1536 x 1152 pixels: 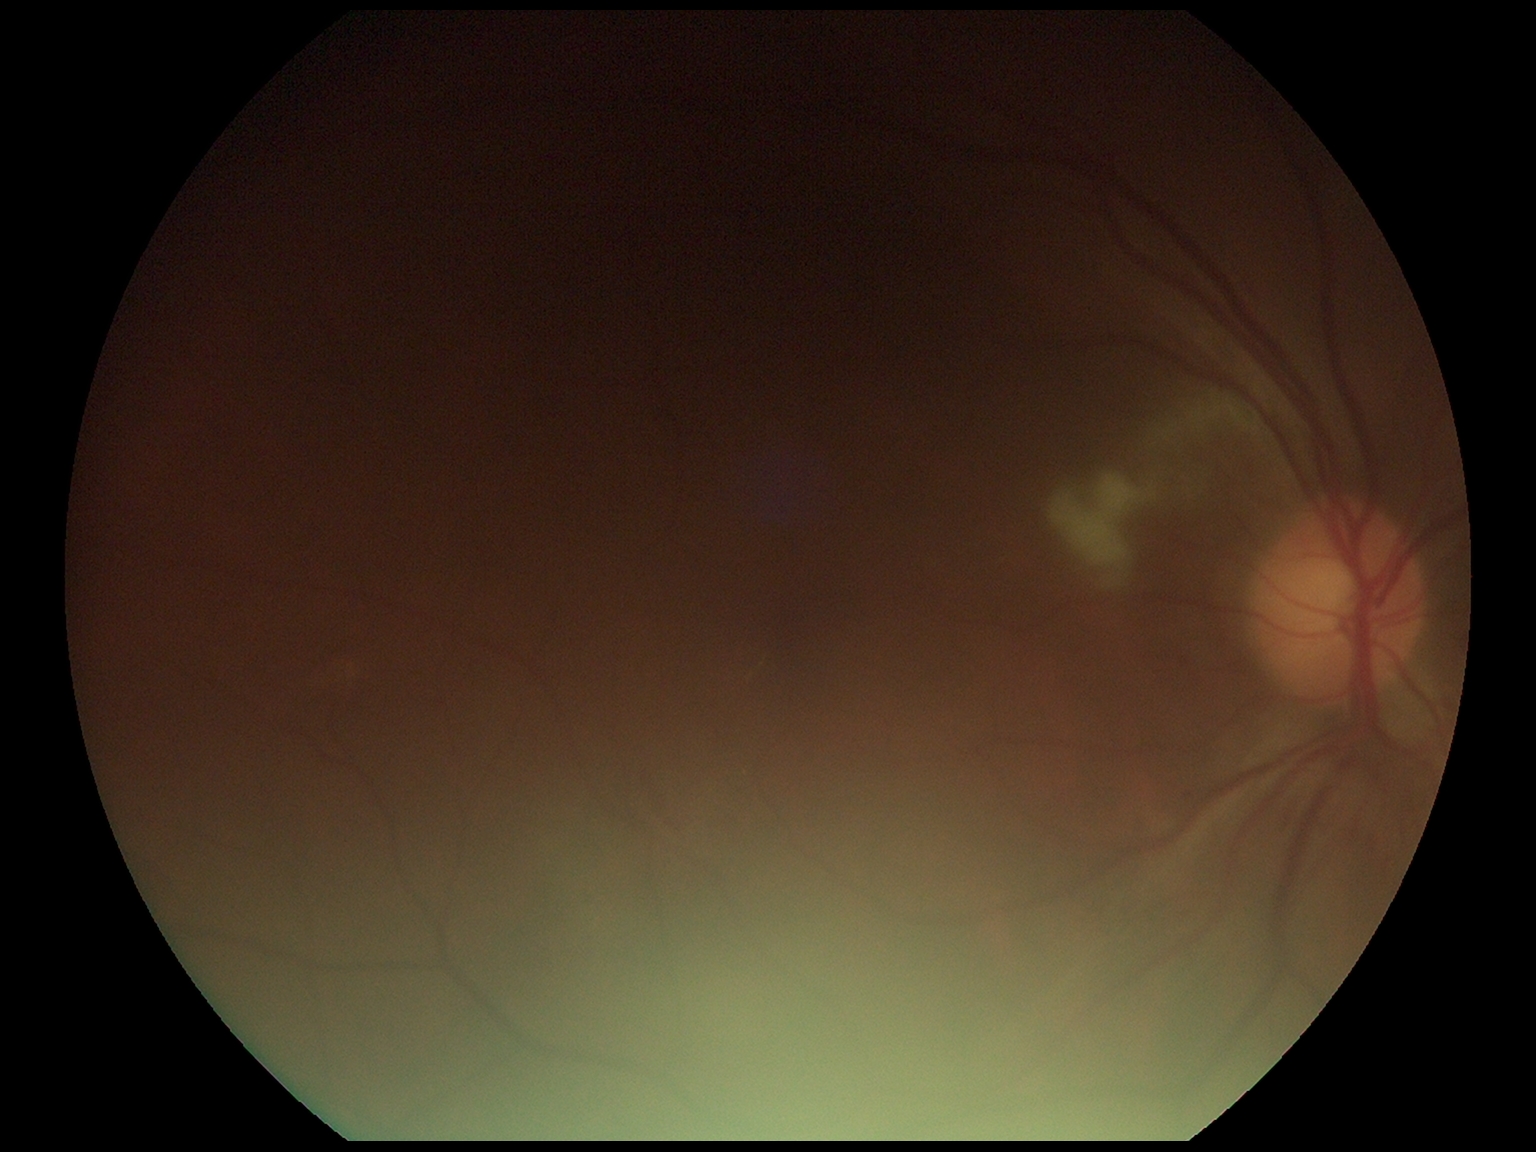

The retinopathy is classified as non-proliferative diabetic retinopathy. DR is grade 2 (moderate NPDR) — more than just microaneurysms but less than severe NPDR.